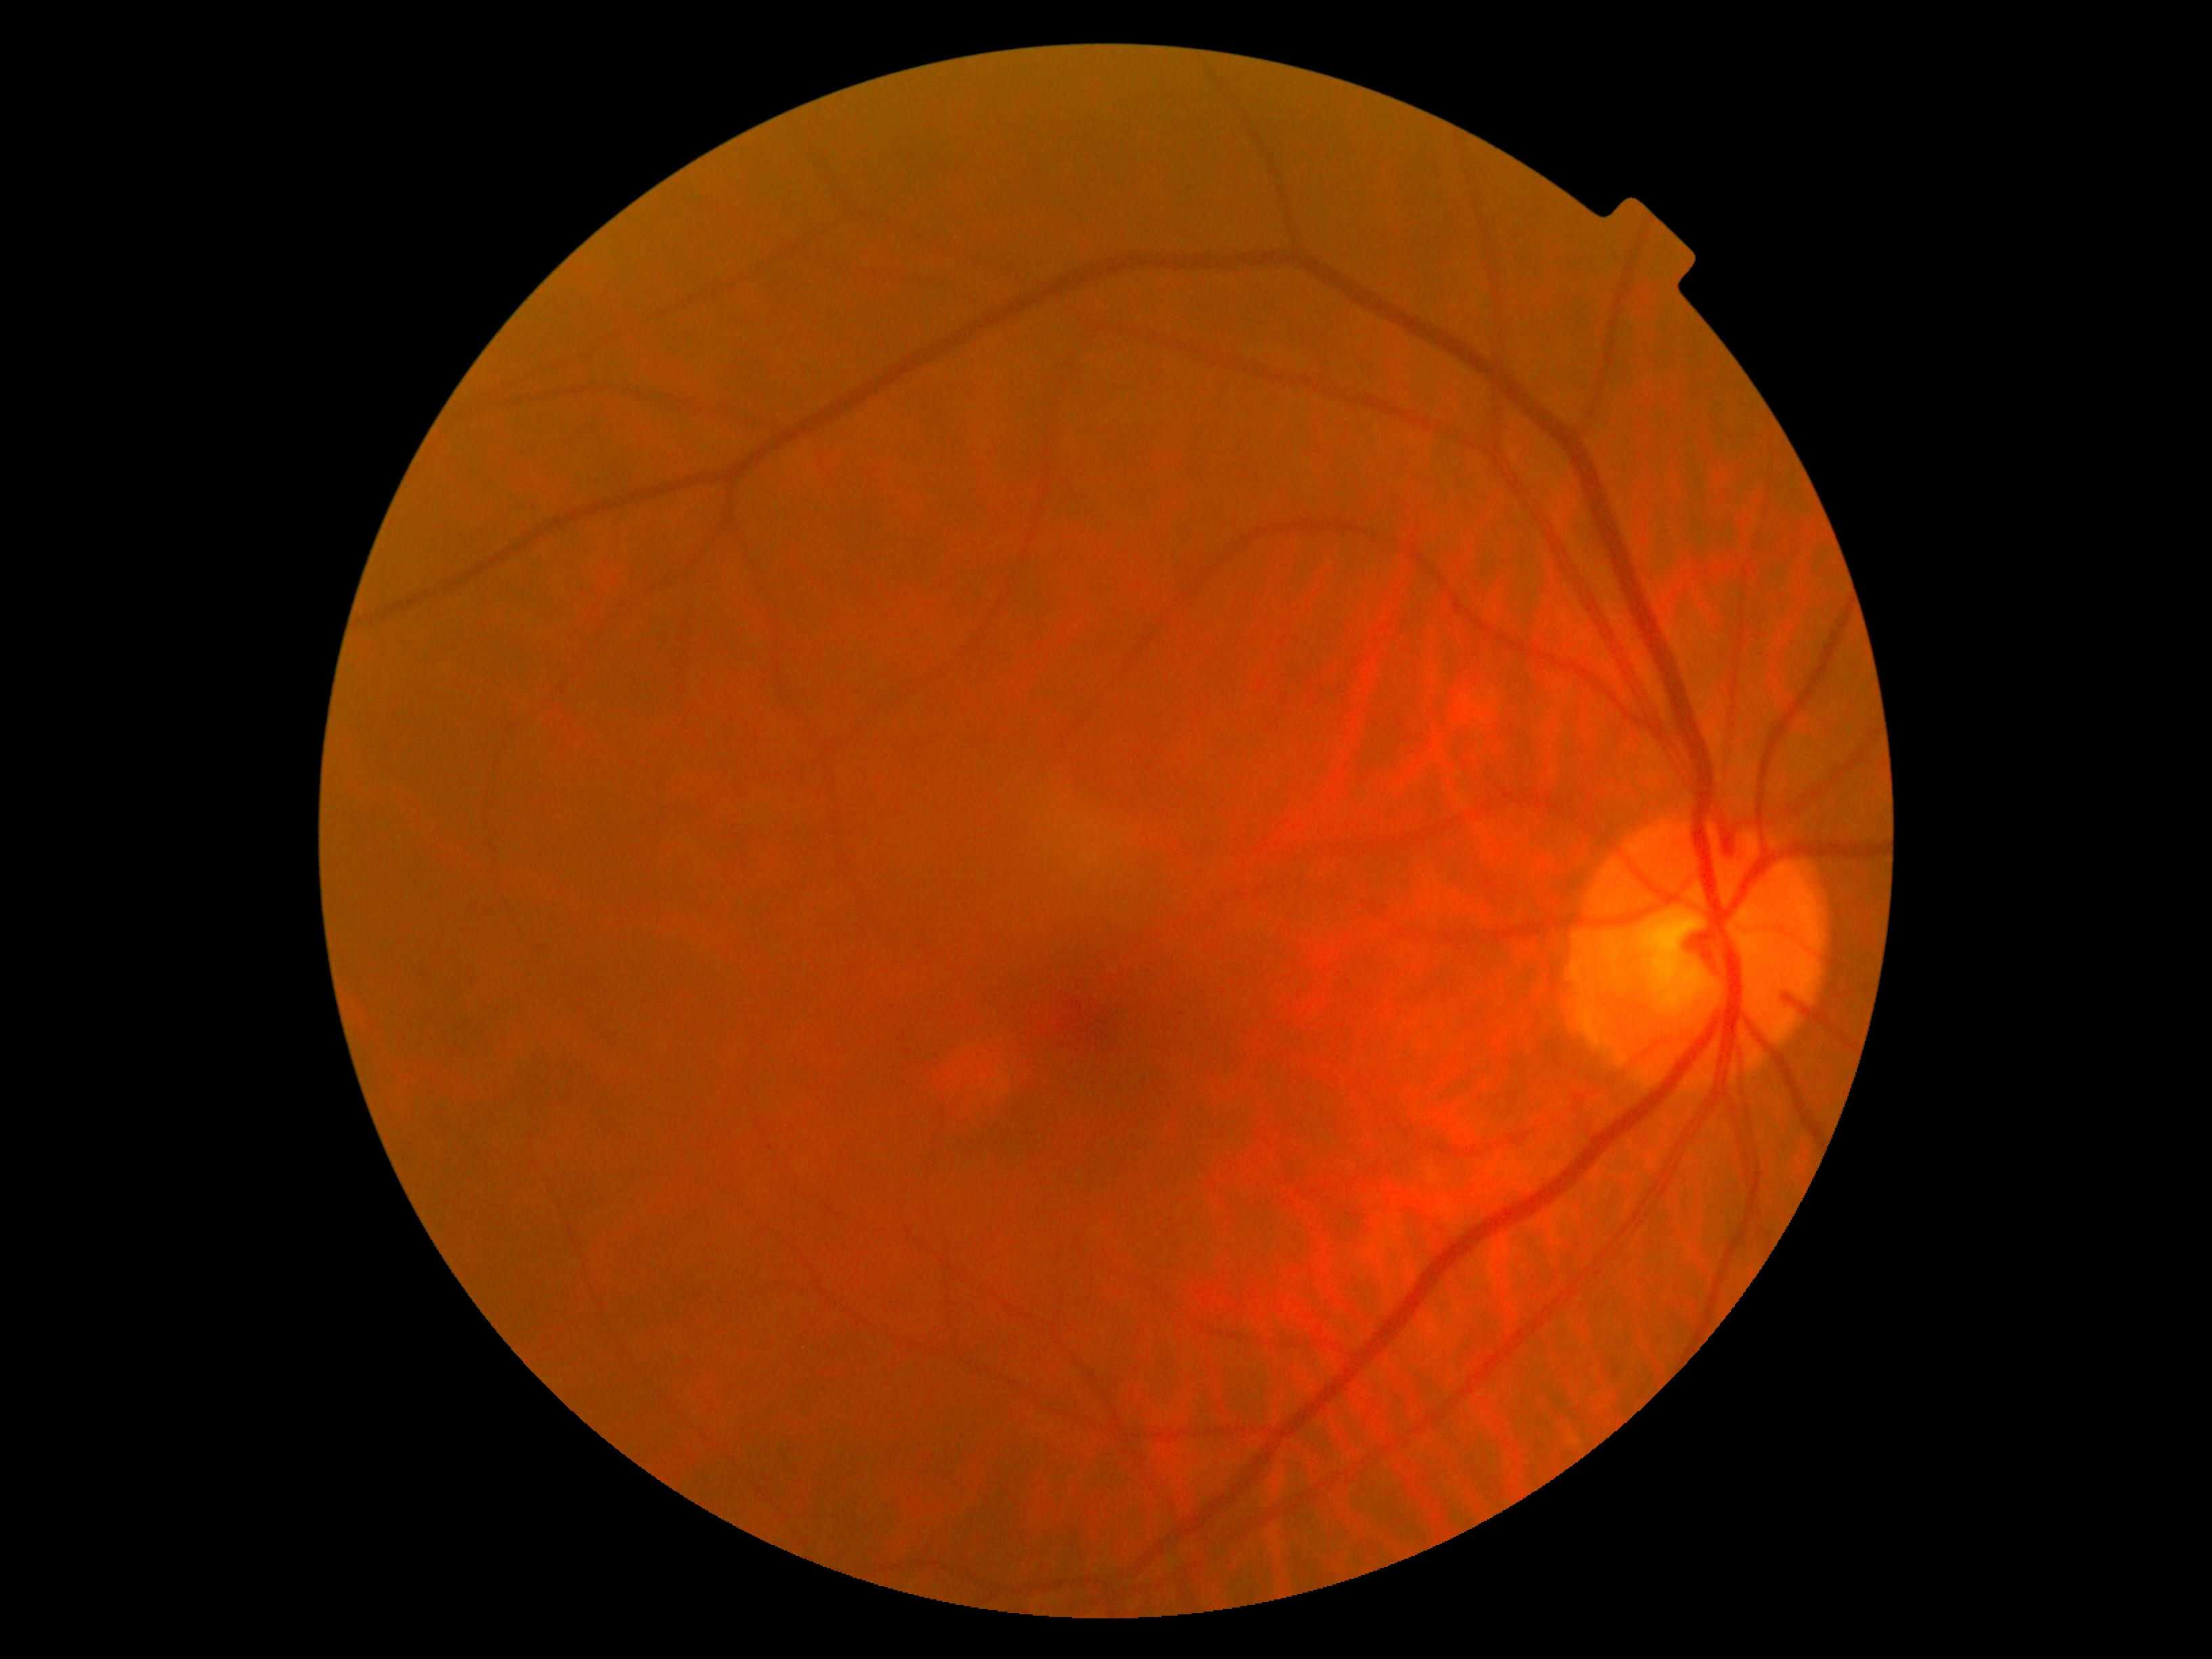 {
  "dr_grade": "no apparent retinopathy (0)"
}